848x848. Retinal fundus photograph:
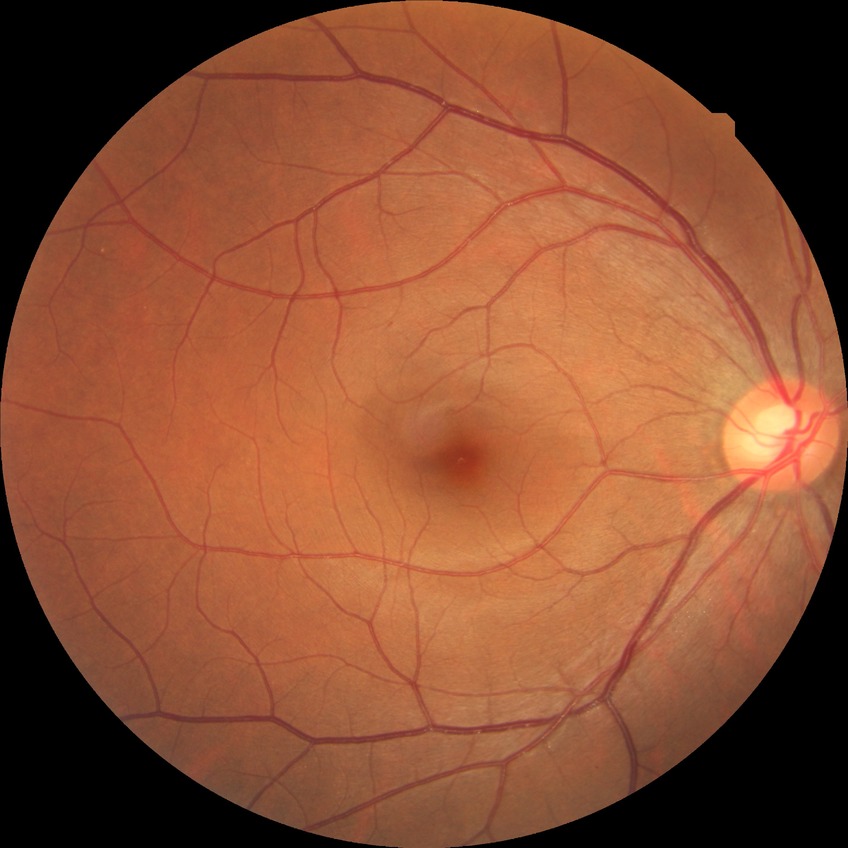

davis_grade: no diabetic retinopathy